Captured after pupil dilation:
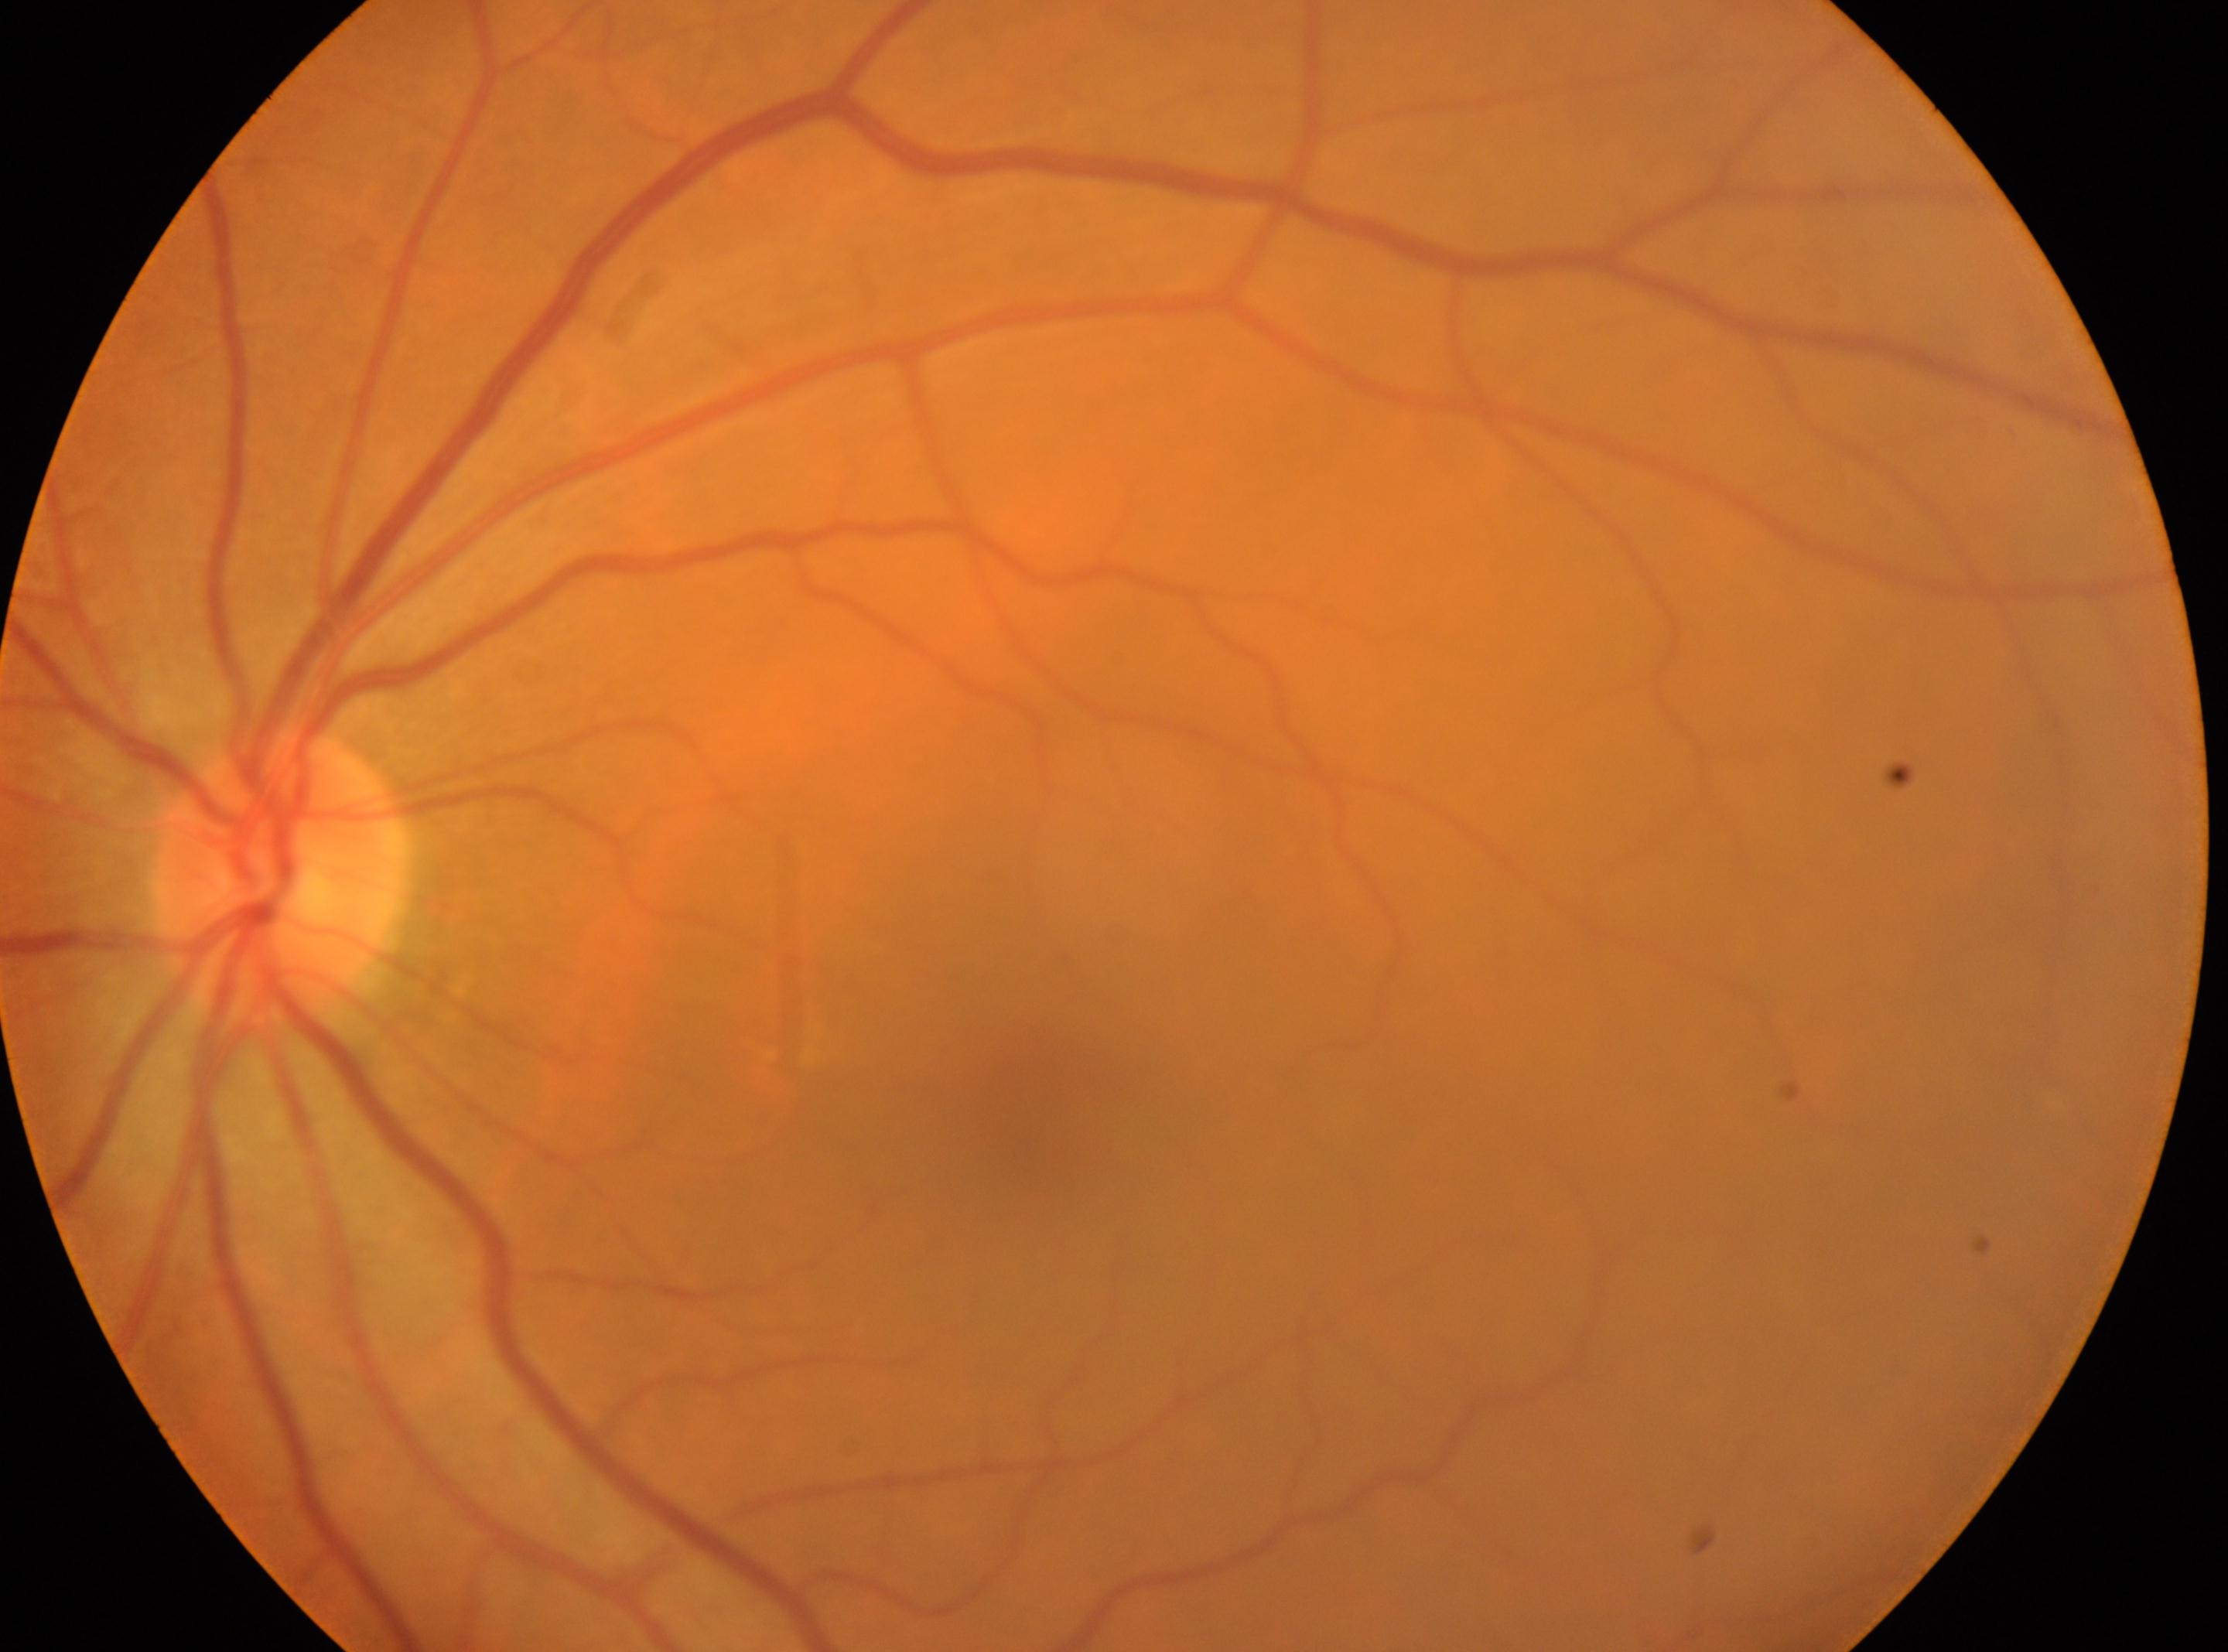 {"eye": "oculus sinister", "dr_grade": "0/4", "optic_disc": "(x: 283, y: 882)", "fovea": "(x: 1041, y: 1118)"}